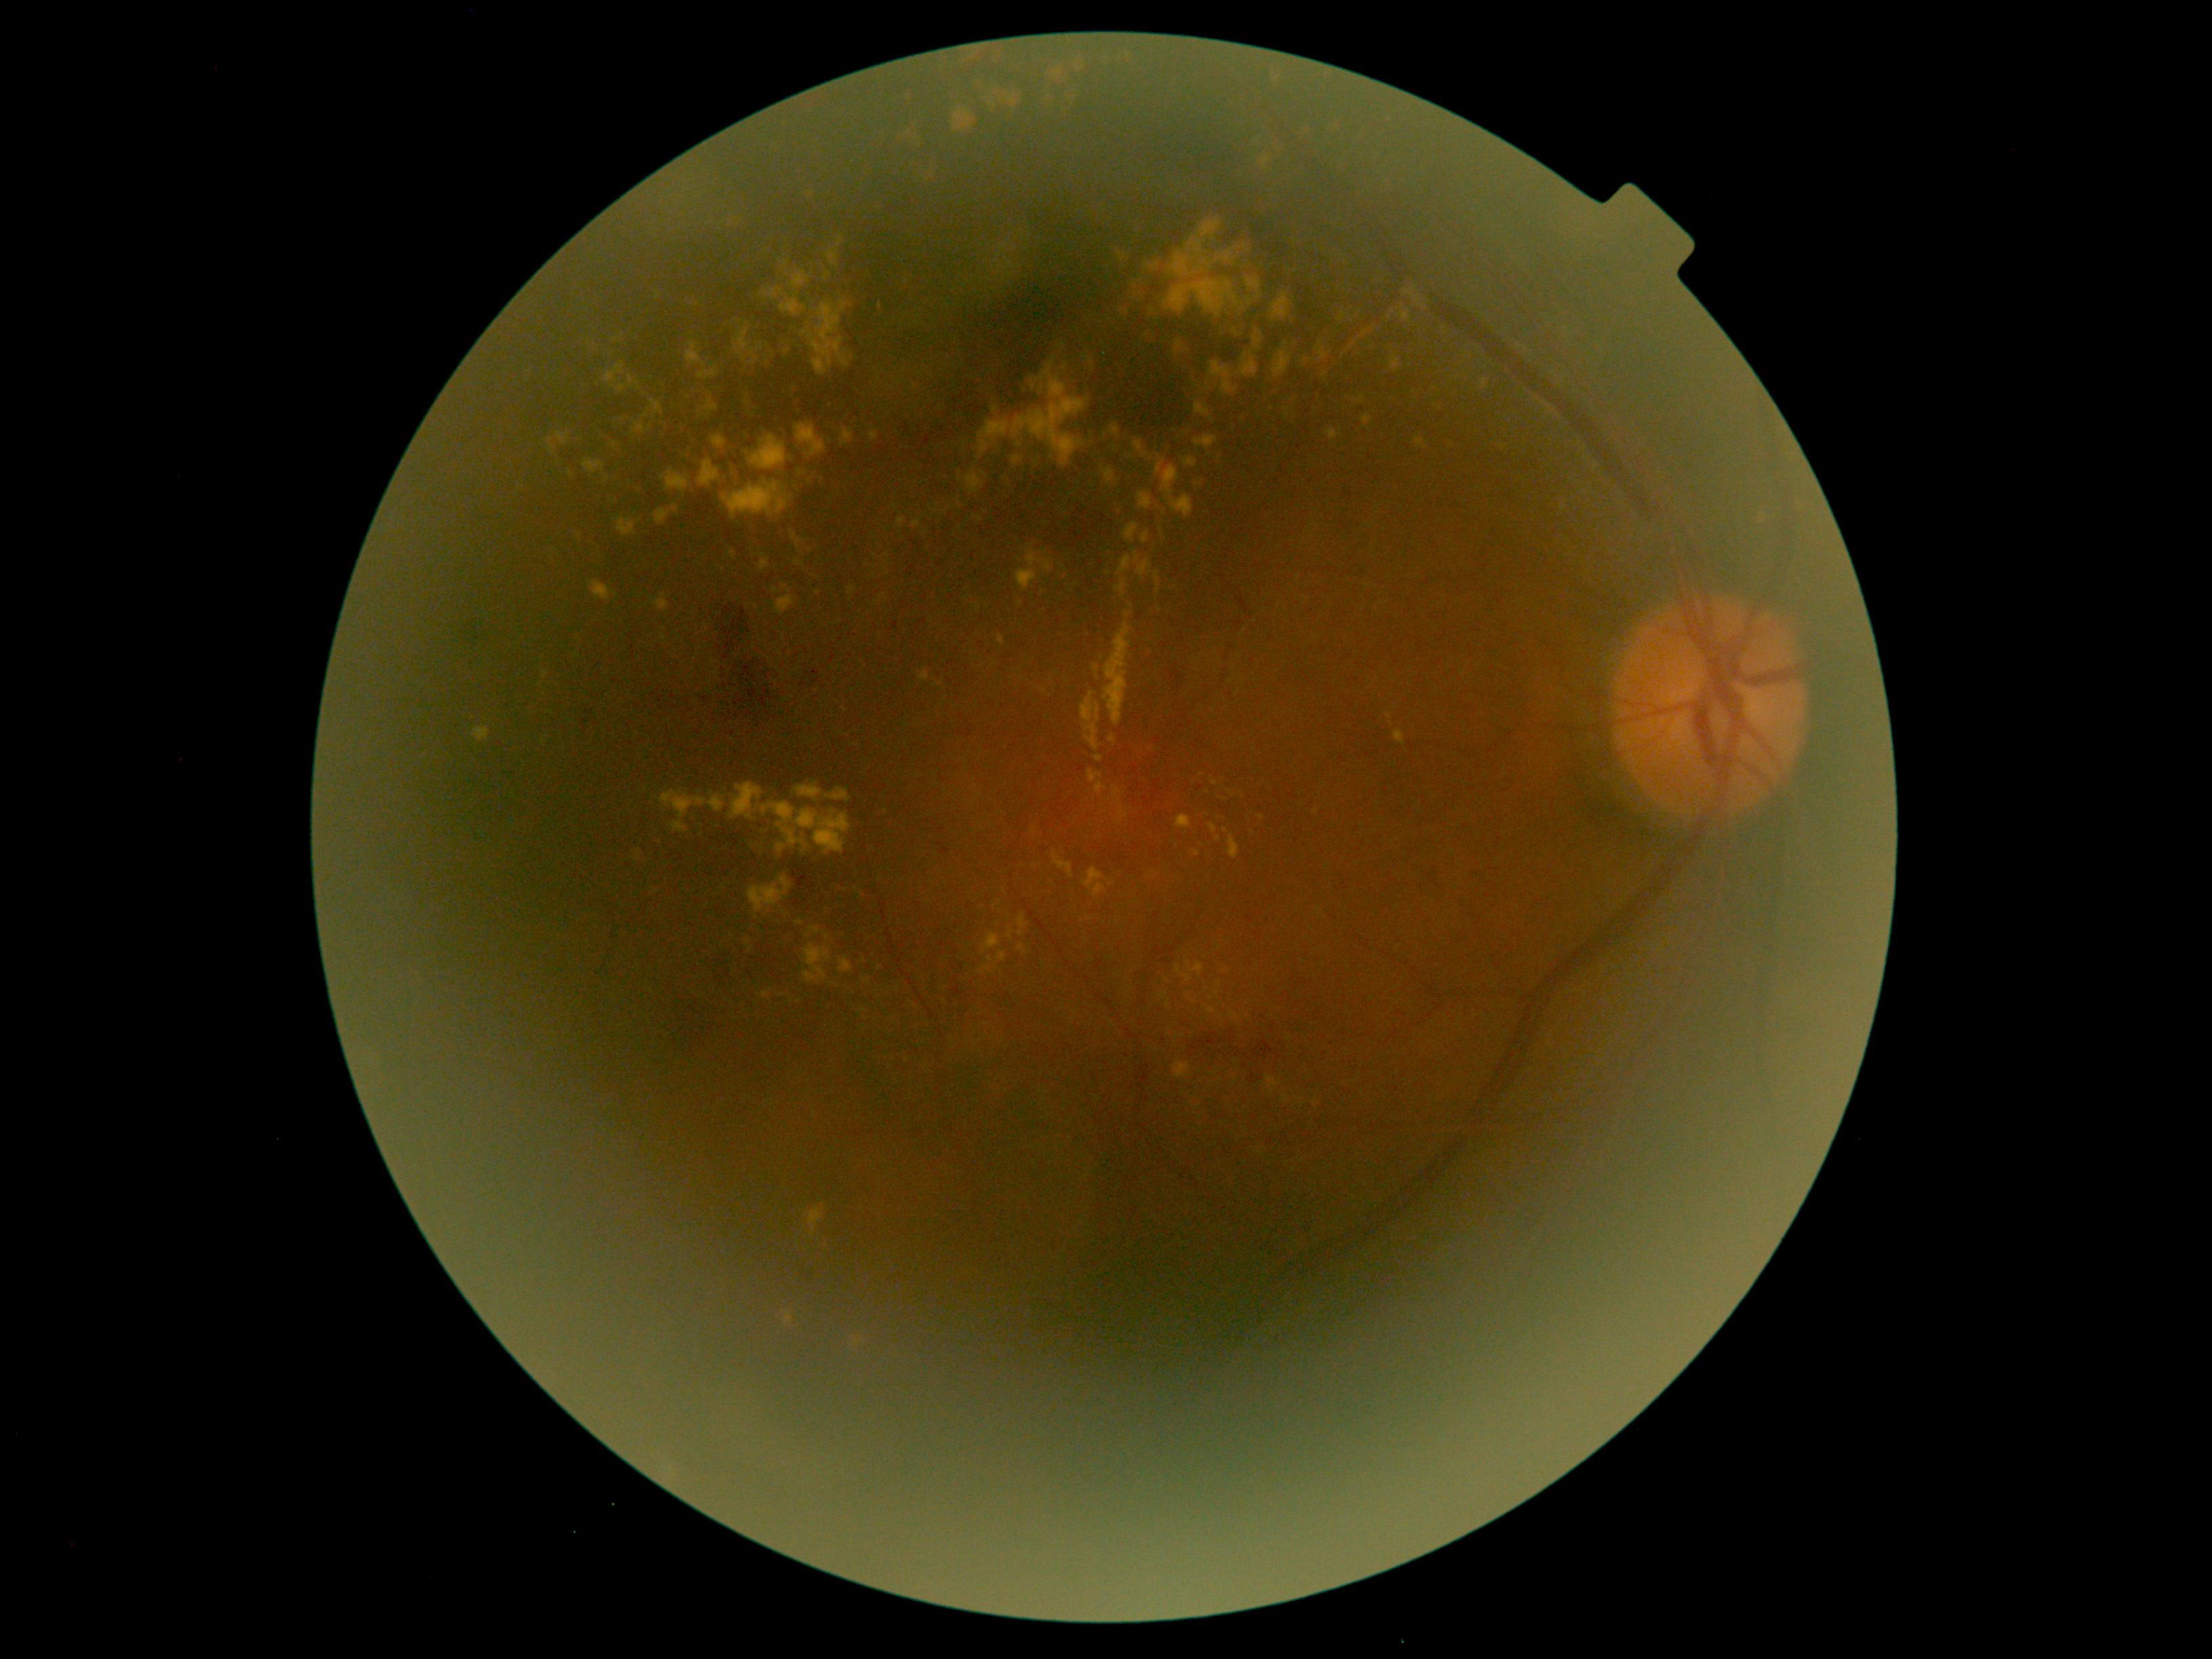
partial: true
dr_grade: 2
dr_grade_name: moderate NPDR
lesions:
  ex:
    - bbox=(800, 300, 851, 377)
    - bbox=(795, 783, 851, 803)
    - bbox=(1305, 359, 1314, 363)
    - bbox=(1093, 665, 1101, 676)
    - bbox=(651, 401, 663, 417)
    - bbox=(913, 520, 921, 528)
    - bbox=(1284, 410, 1290, 419)
    - bbox=(1141, 532, 1150, 544)
    - bbox=(808, 1208, 823, 1237)
    - bbox=(699, 364, 719, 380)
    - bbox=(475, 726, 490, 742)
    - bbox=(1391, 357, 1401, 372)
    - bbox=(806, 186, 829, 209)
  ex_small:
    - (1218; 839)
    - (1168; 1005)
    - (1288; 1037)
    - (1236; 333)
    - (1212; 1074)
    - (951; 508)
    - (1231; 793)